45° FOV. Image size 1932x1932. Color fundus image: 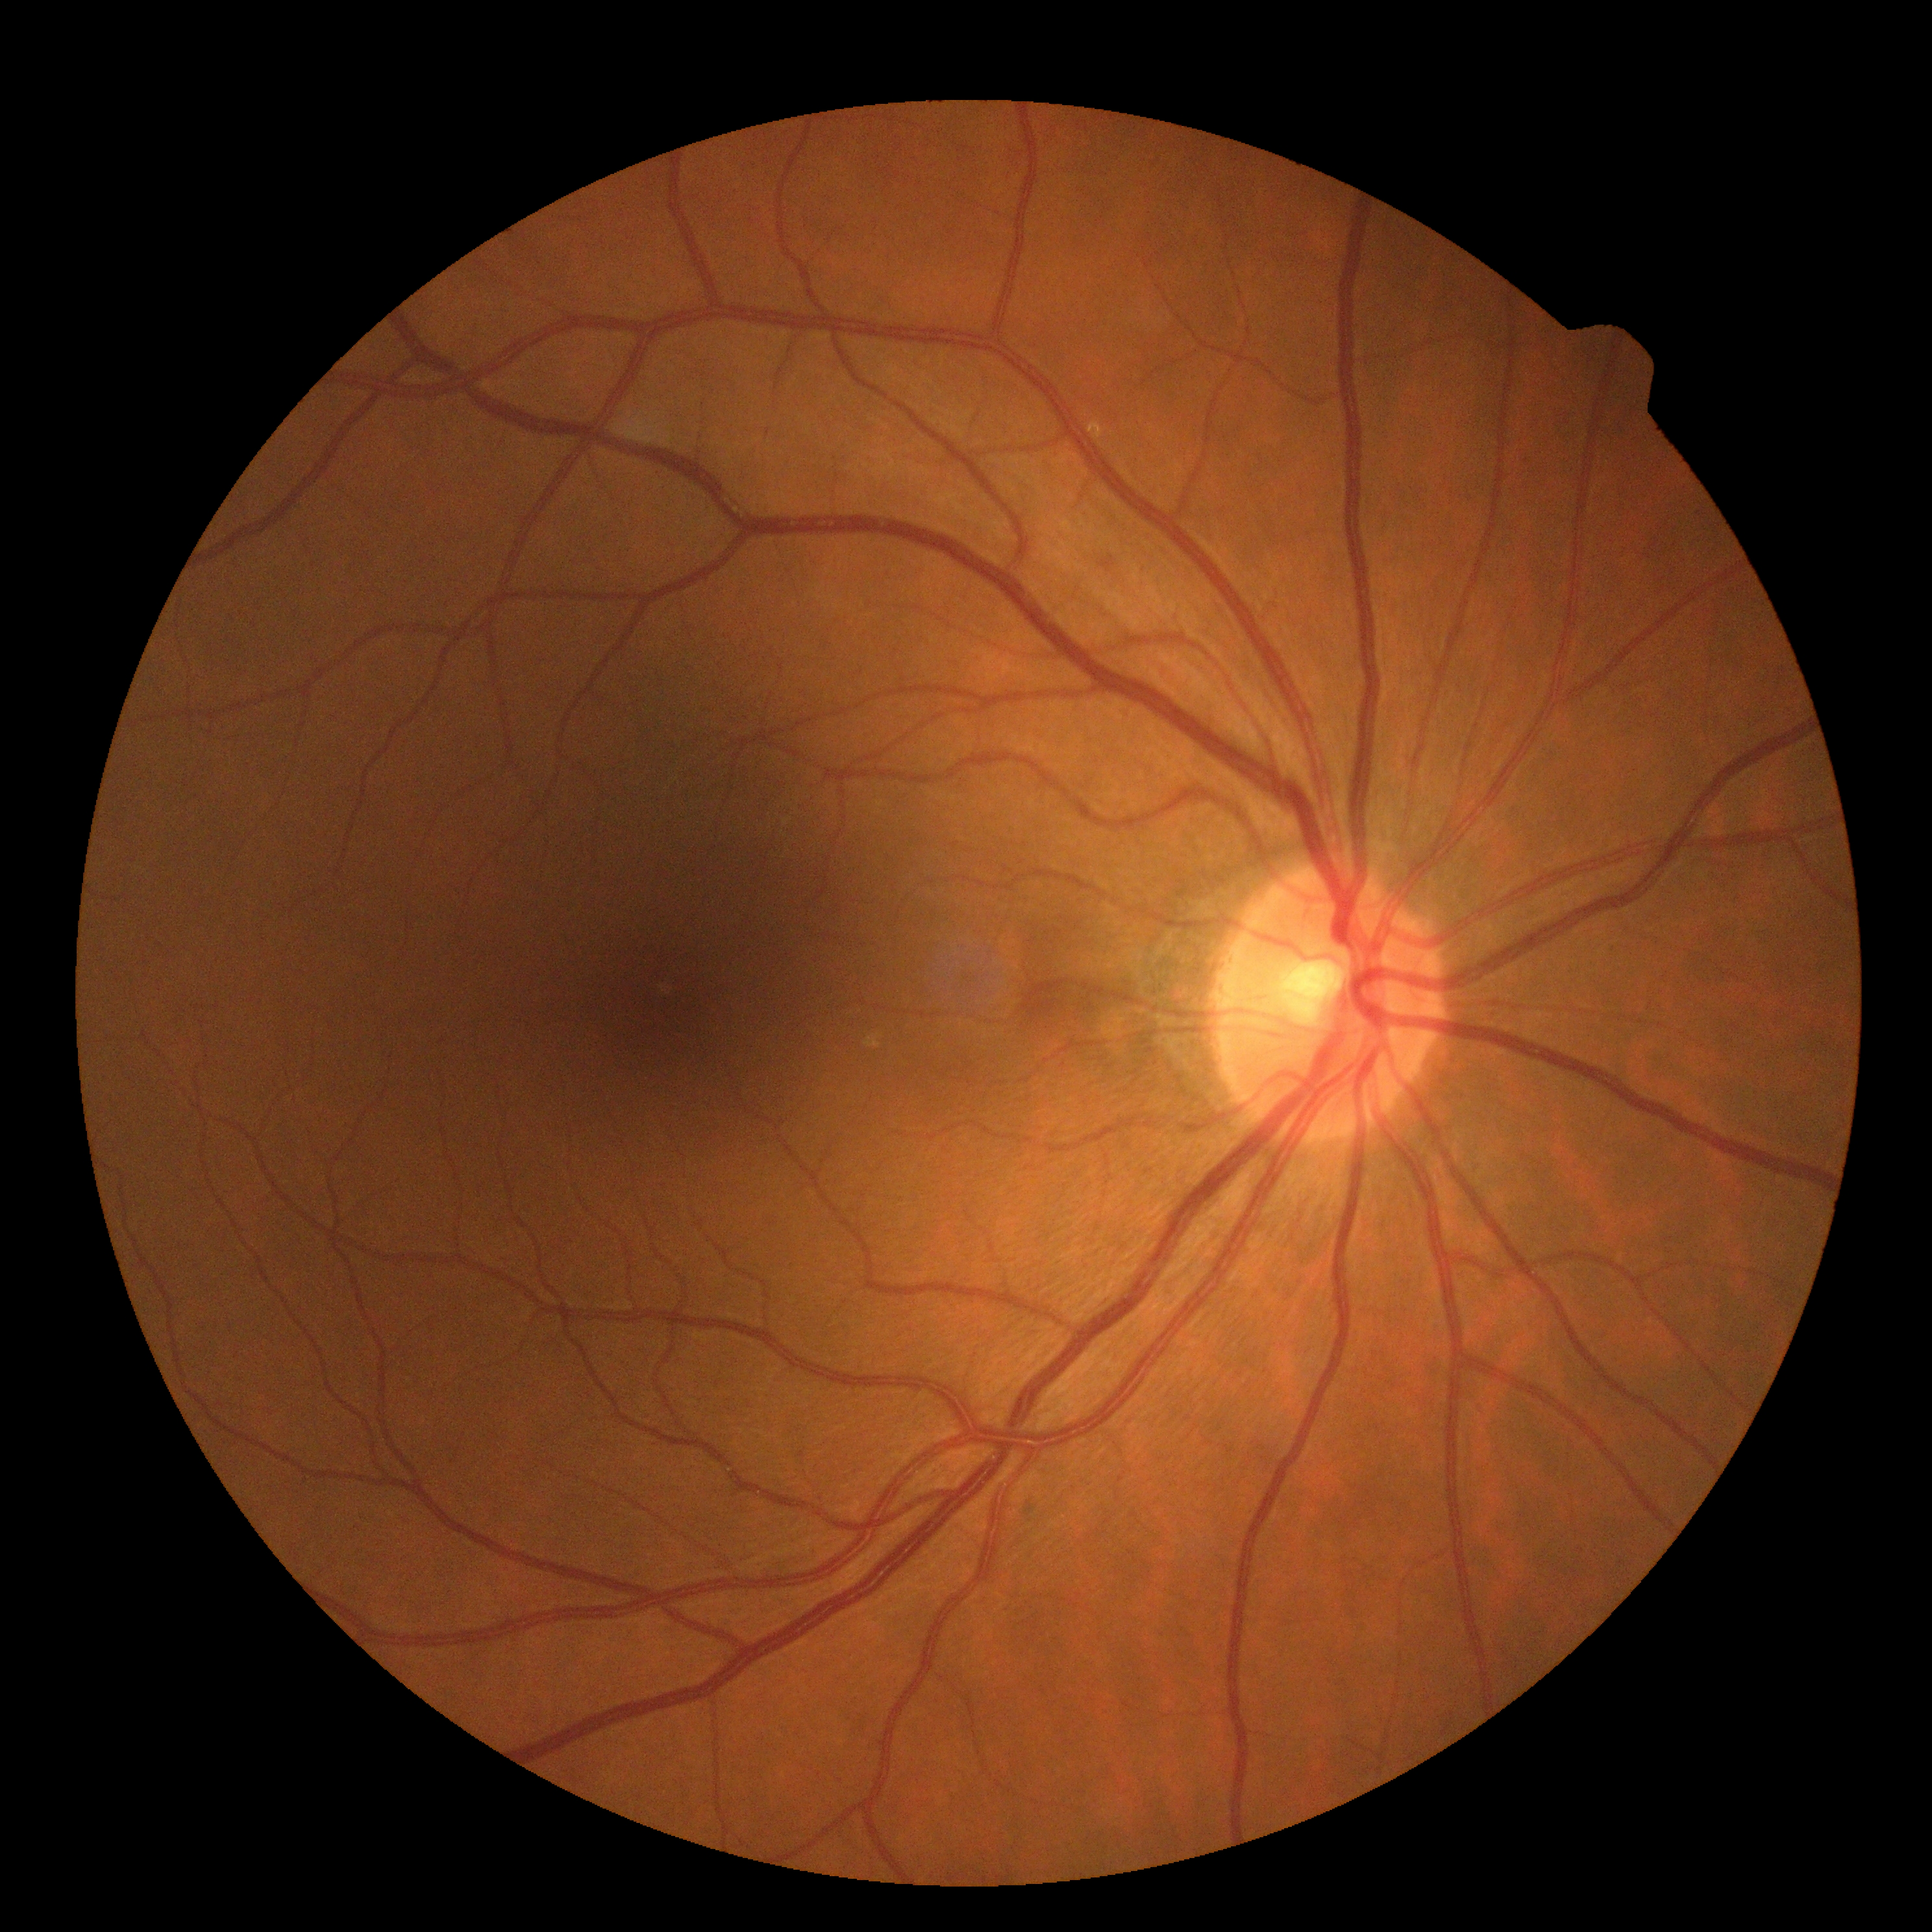
DR impression: no DR findings, DR stage: 0 — no visible signs of diabetic retinopathy.